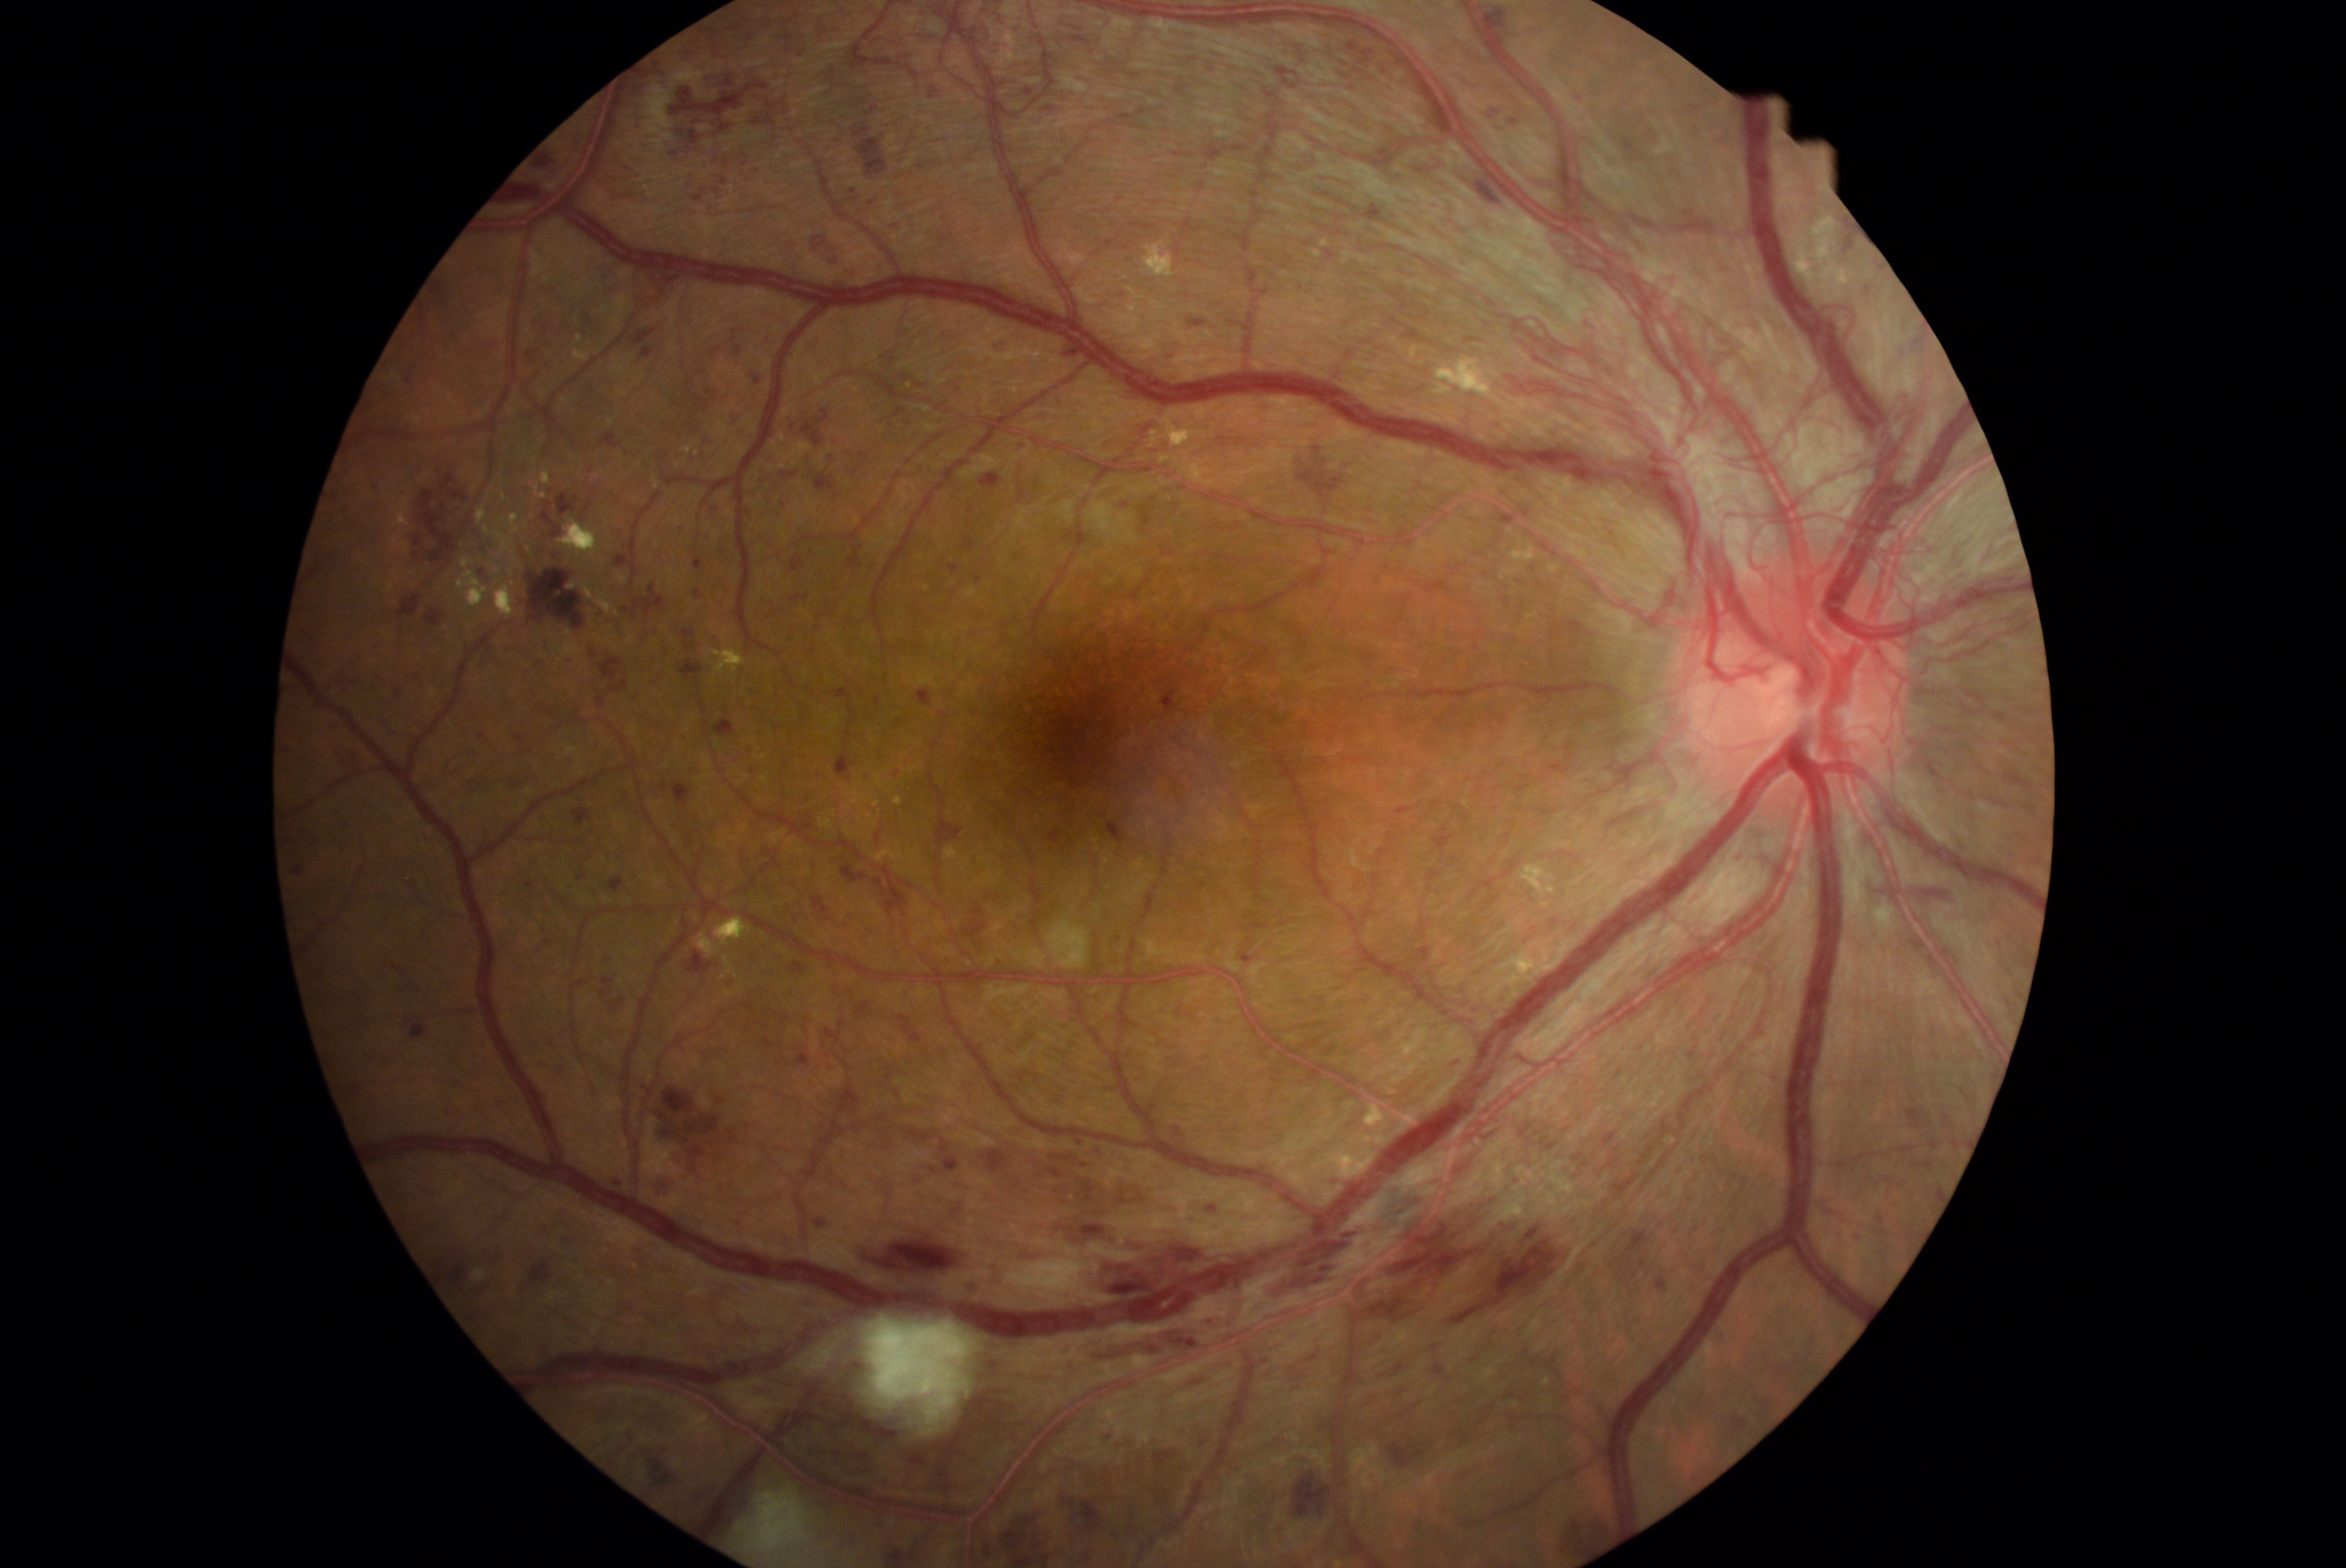 Diabetic retinopathy (DR): PDR (grade 4). Hemorrhages (HEs) (partial list) at BBox(683, 628, 697, 648) | BBox(714, 598, 725, 611) | BBox(1456, 1392, 1528, 1446) | BBox(311, 557, 332, 579) | BBox(802, 1147, 826, 1180) | BBox(634, 82, 652, 96) | BBox(868, 200, 877, 208) | BBox(603, 990, 611, 996) | BBox(1693, 1266, 1712, 1277) | BBox(721, 176, 730, 186) | BBox(1632, 1272, 1636, 1280) | BBox(1469, 1319, 1513, 1367) | BBox(1008, 81, 1036, 101) | BBox(405, 366, 416, 382) | BBox(1621, 137, 1641, 153) | BBox(1313, 1334, 1321, 1348) | BBox(808, 230, 841, 266) | BBox(674, 783, 691, 805). Small HEs approximately at 289/752.